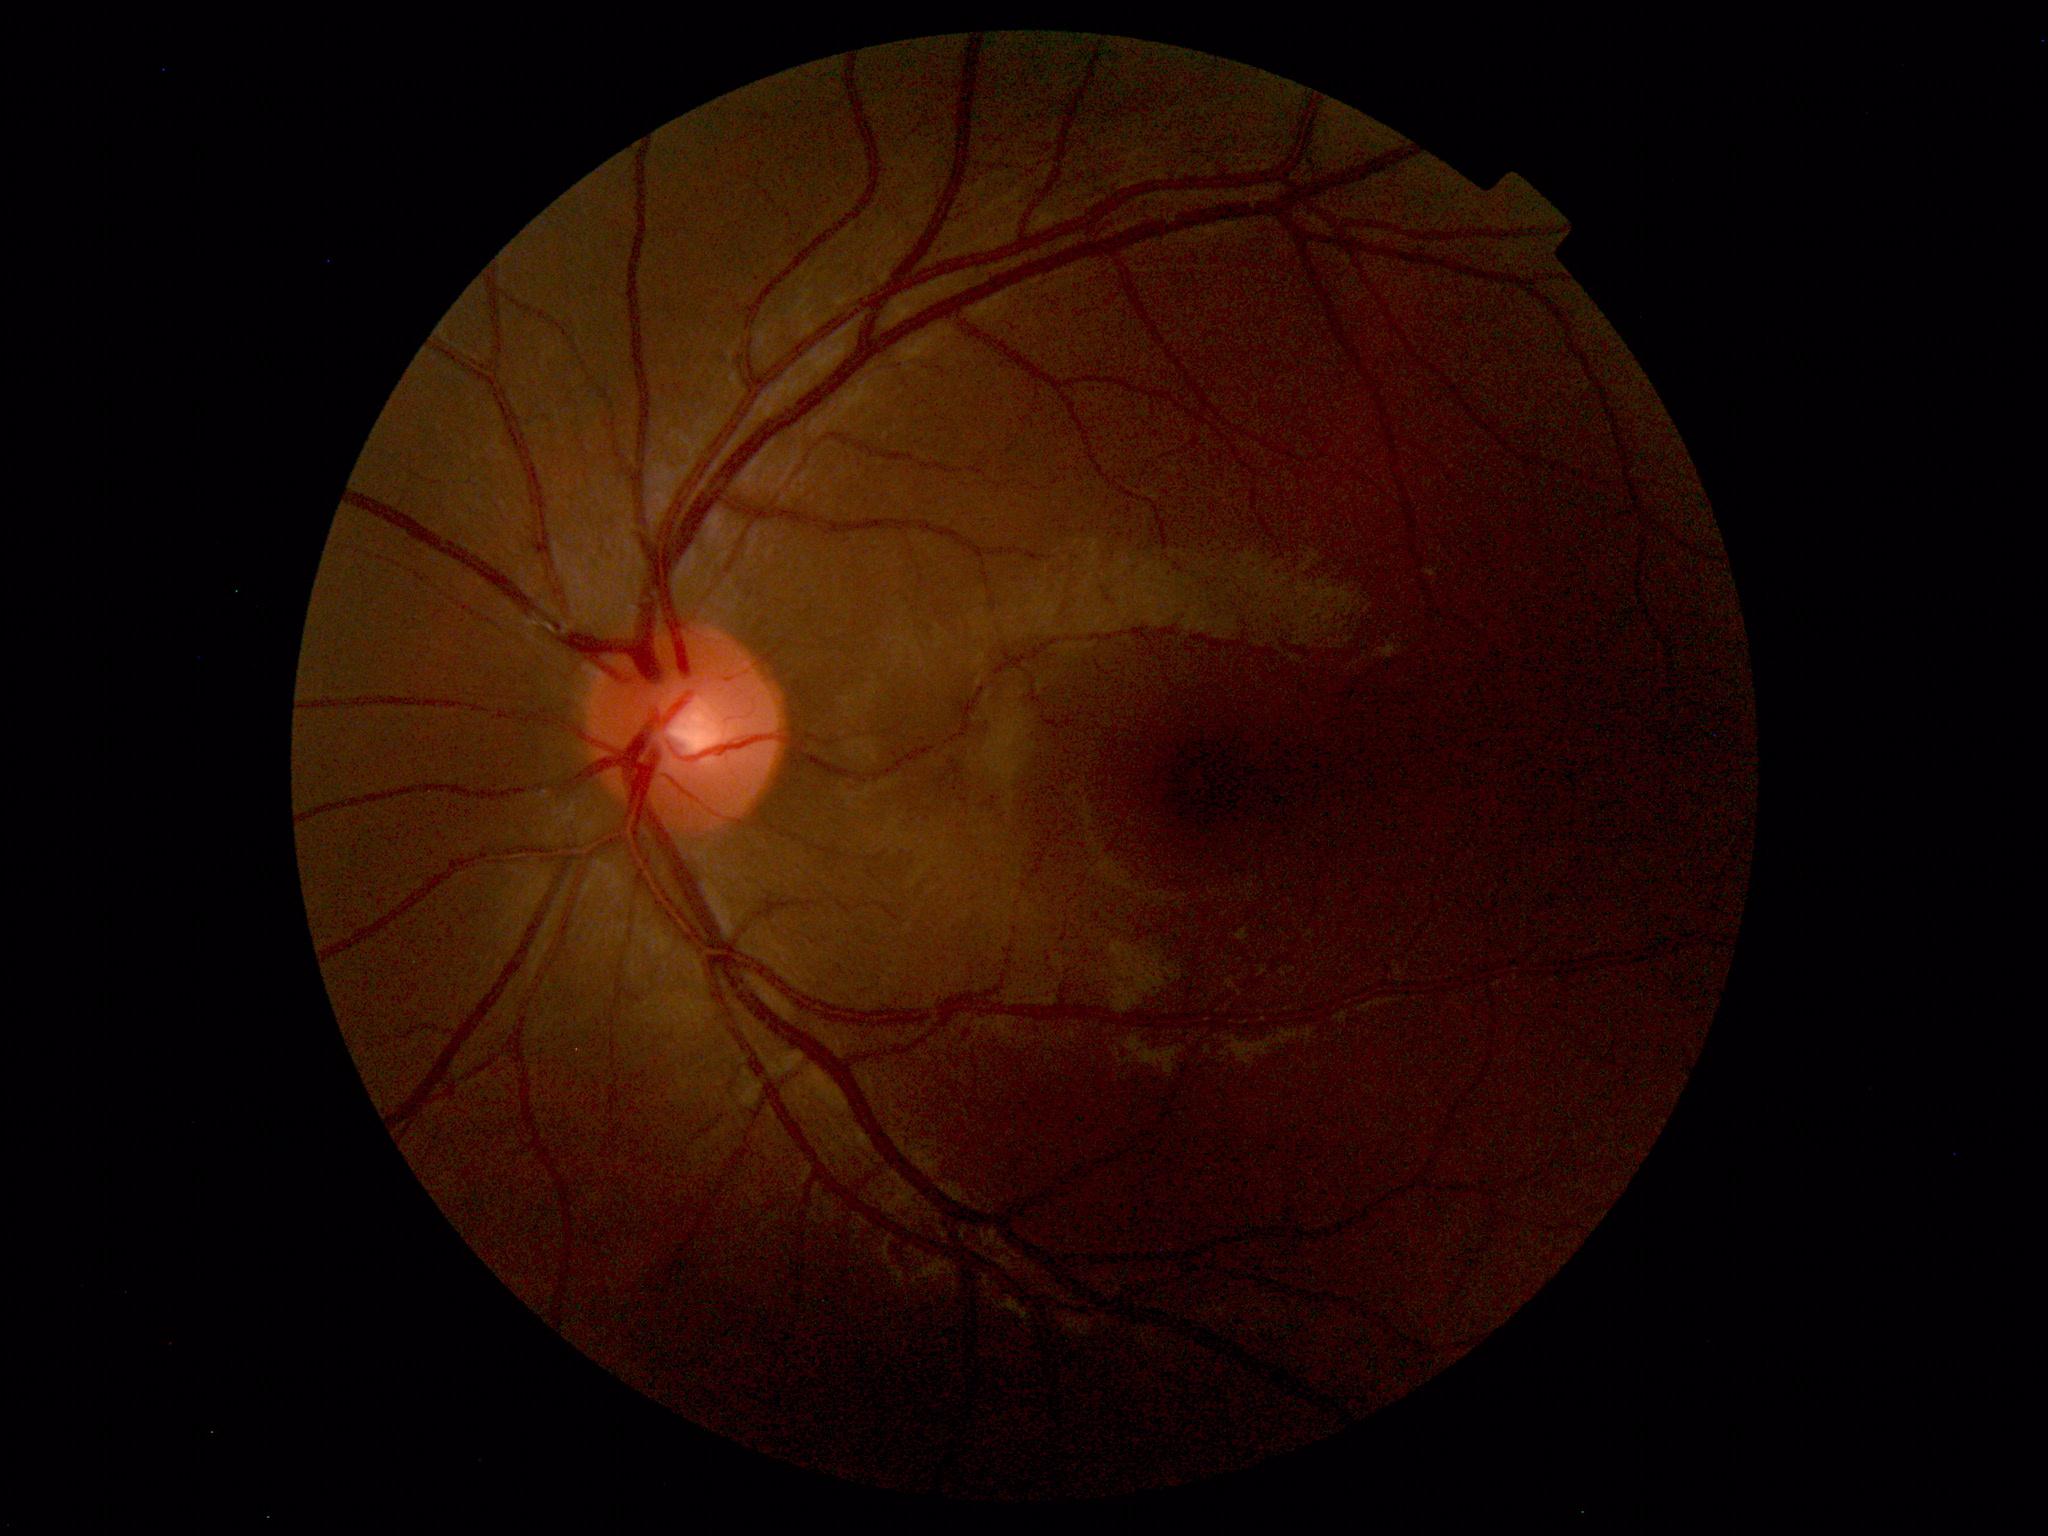
The fundus appears normal with no pathological findings.